Acquired with a NIDEK AFC-230; 848 by 848 pixels.
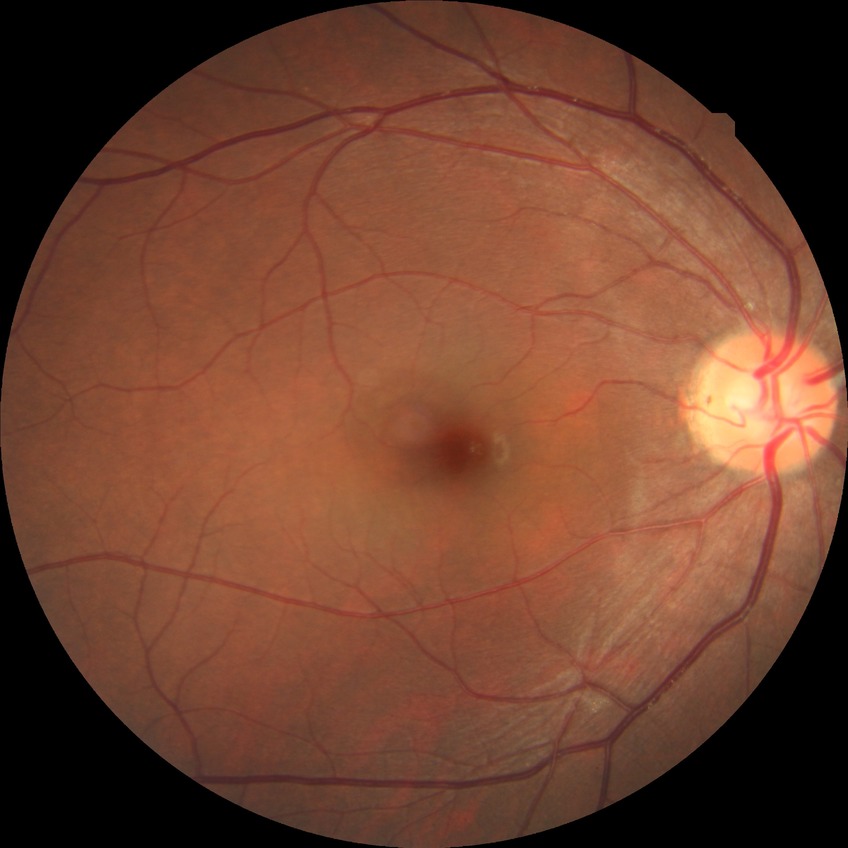
Diabetic retinopathy grade: no diabetic retinopathy.